45° FOV, posterior pole photograph, without pupil dilation.
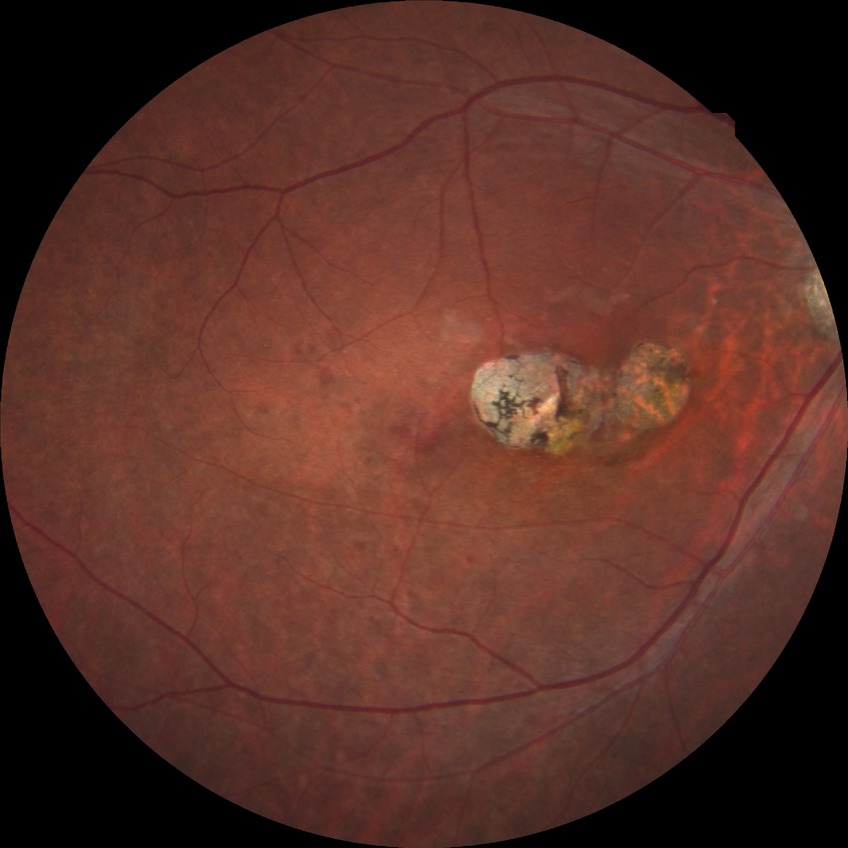 Findings:
* modified Davis grading — no diabetic retinopathy